Color fundus image
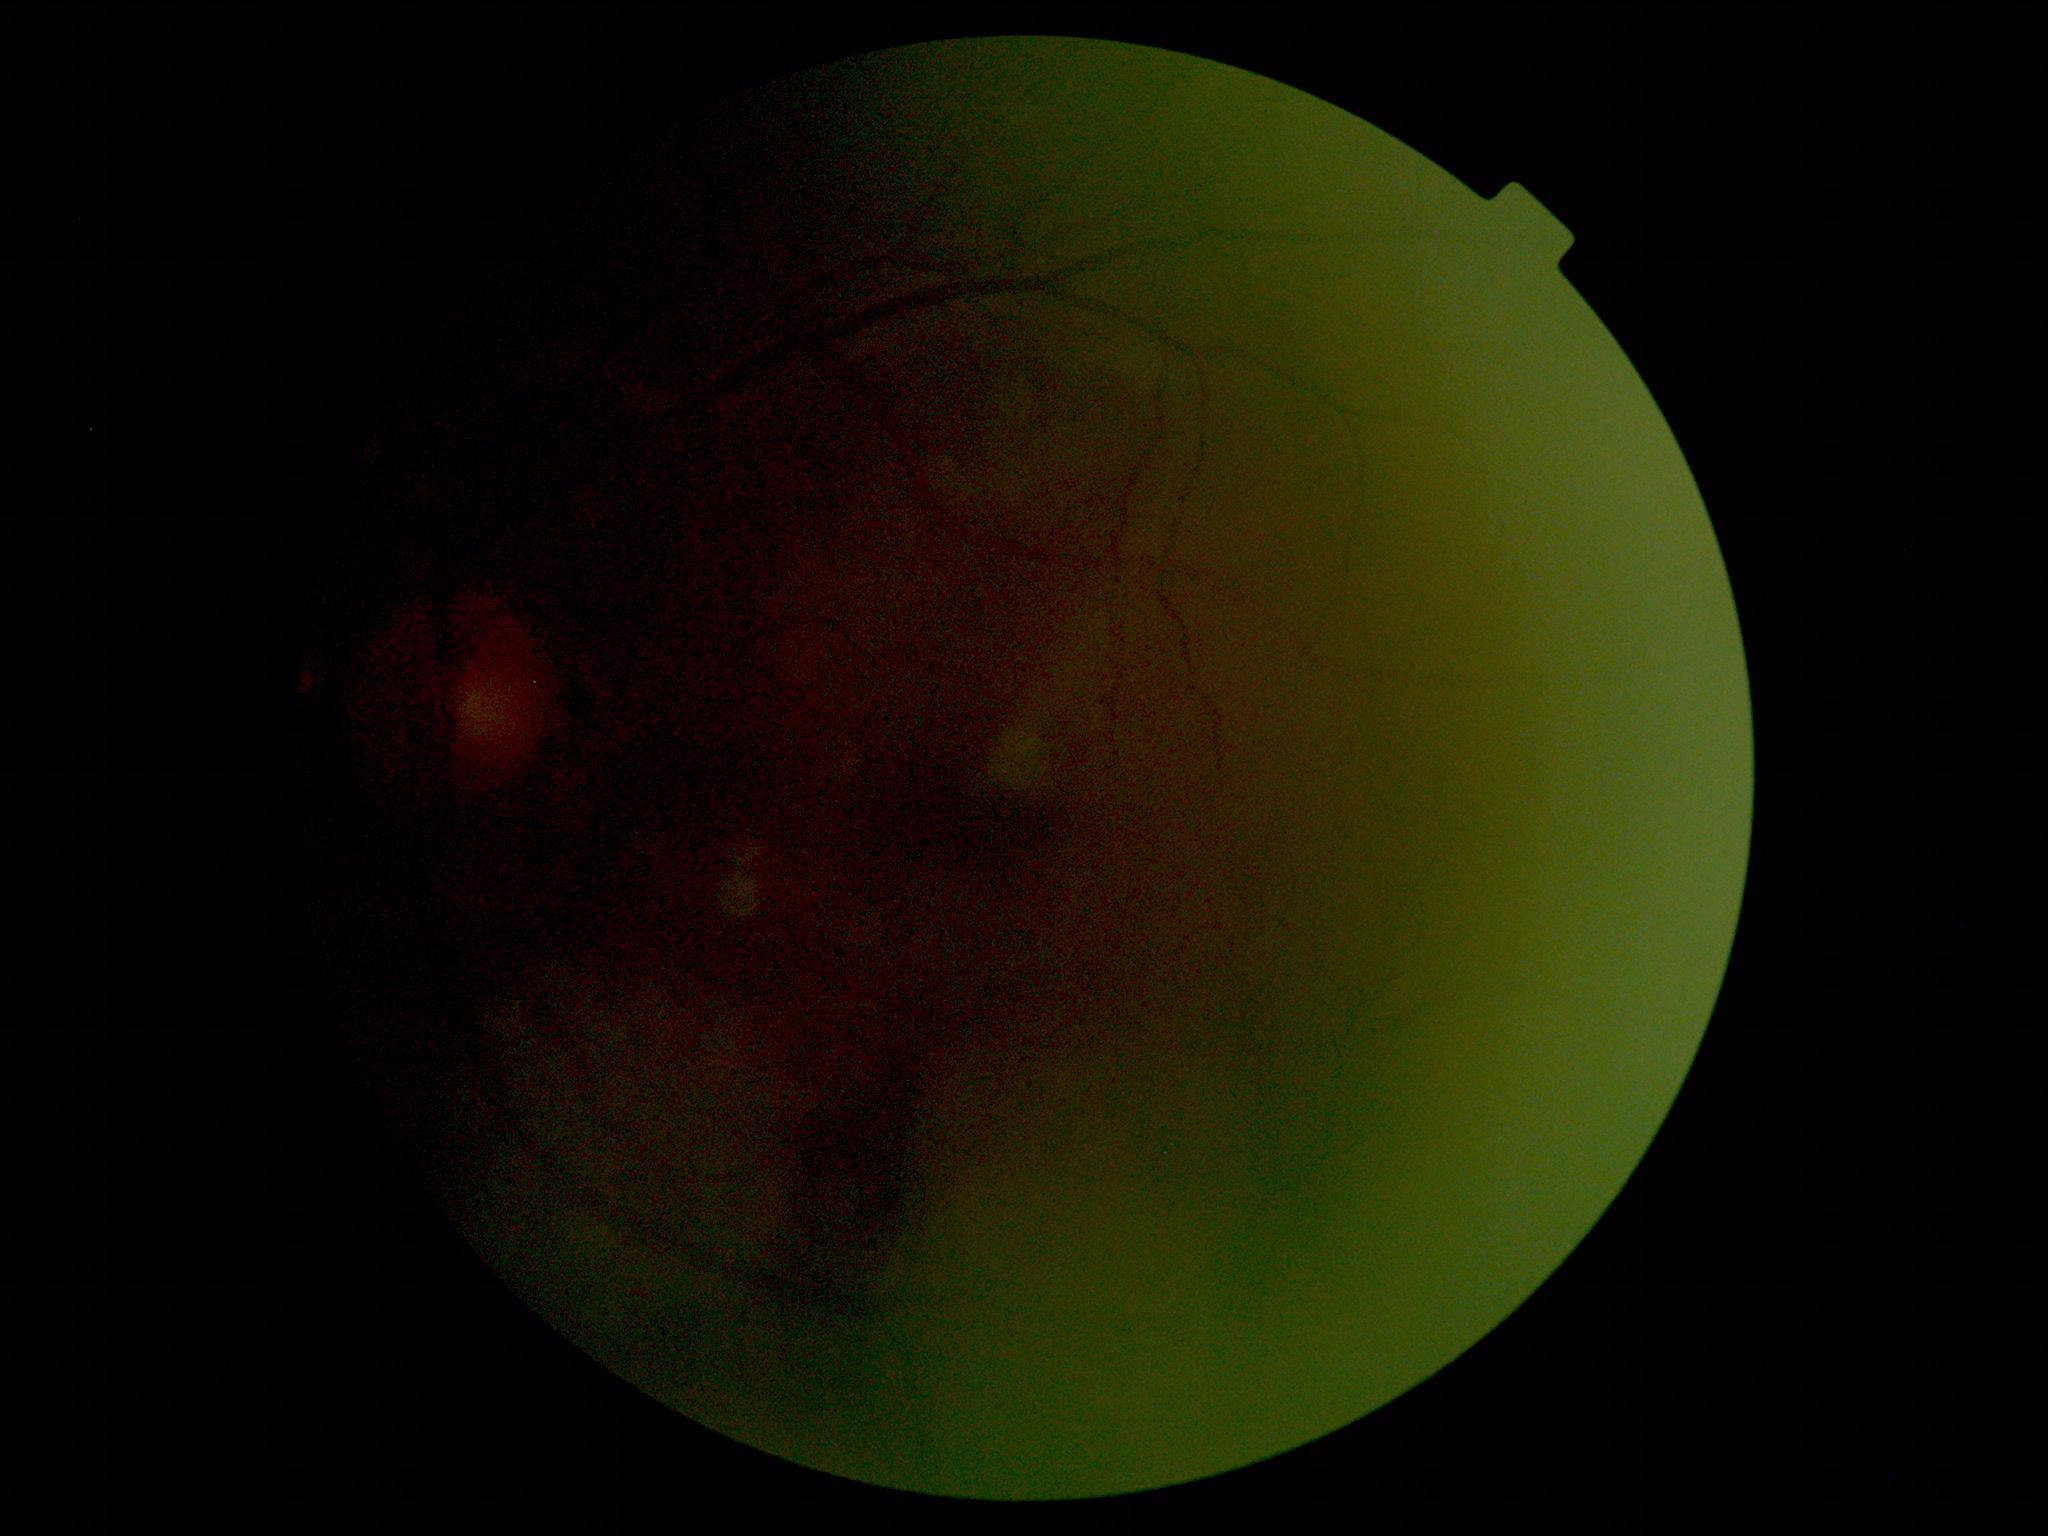
{
  "quality": "insufficient",
  "dr_grade": "ungradable due to poor image quality"
}